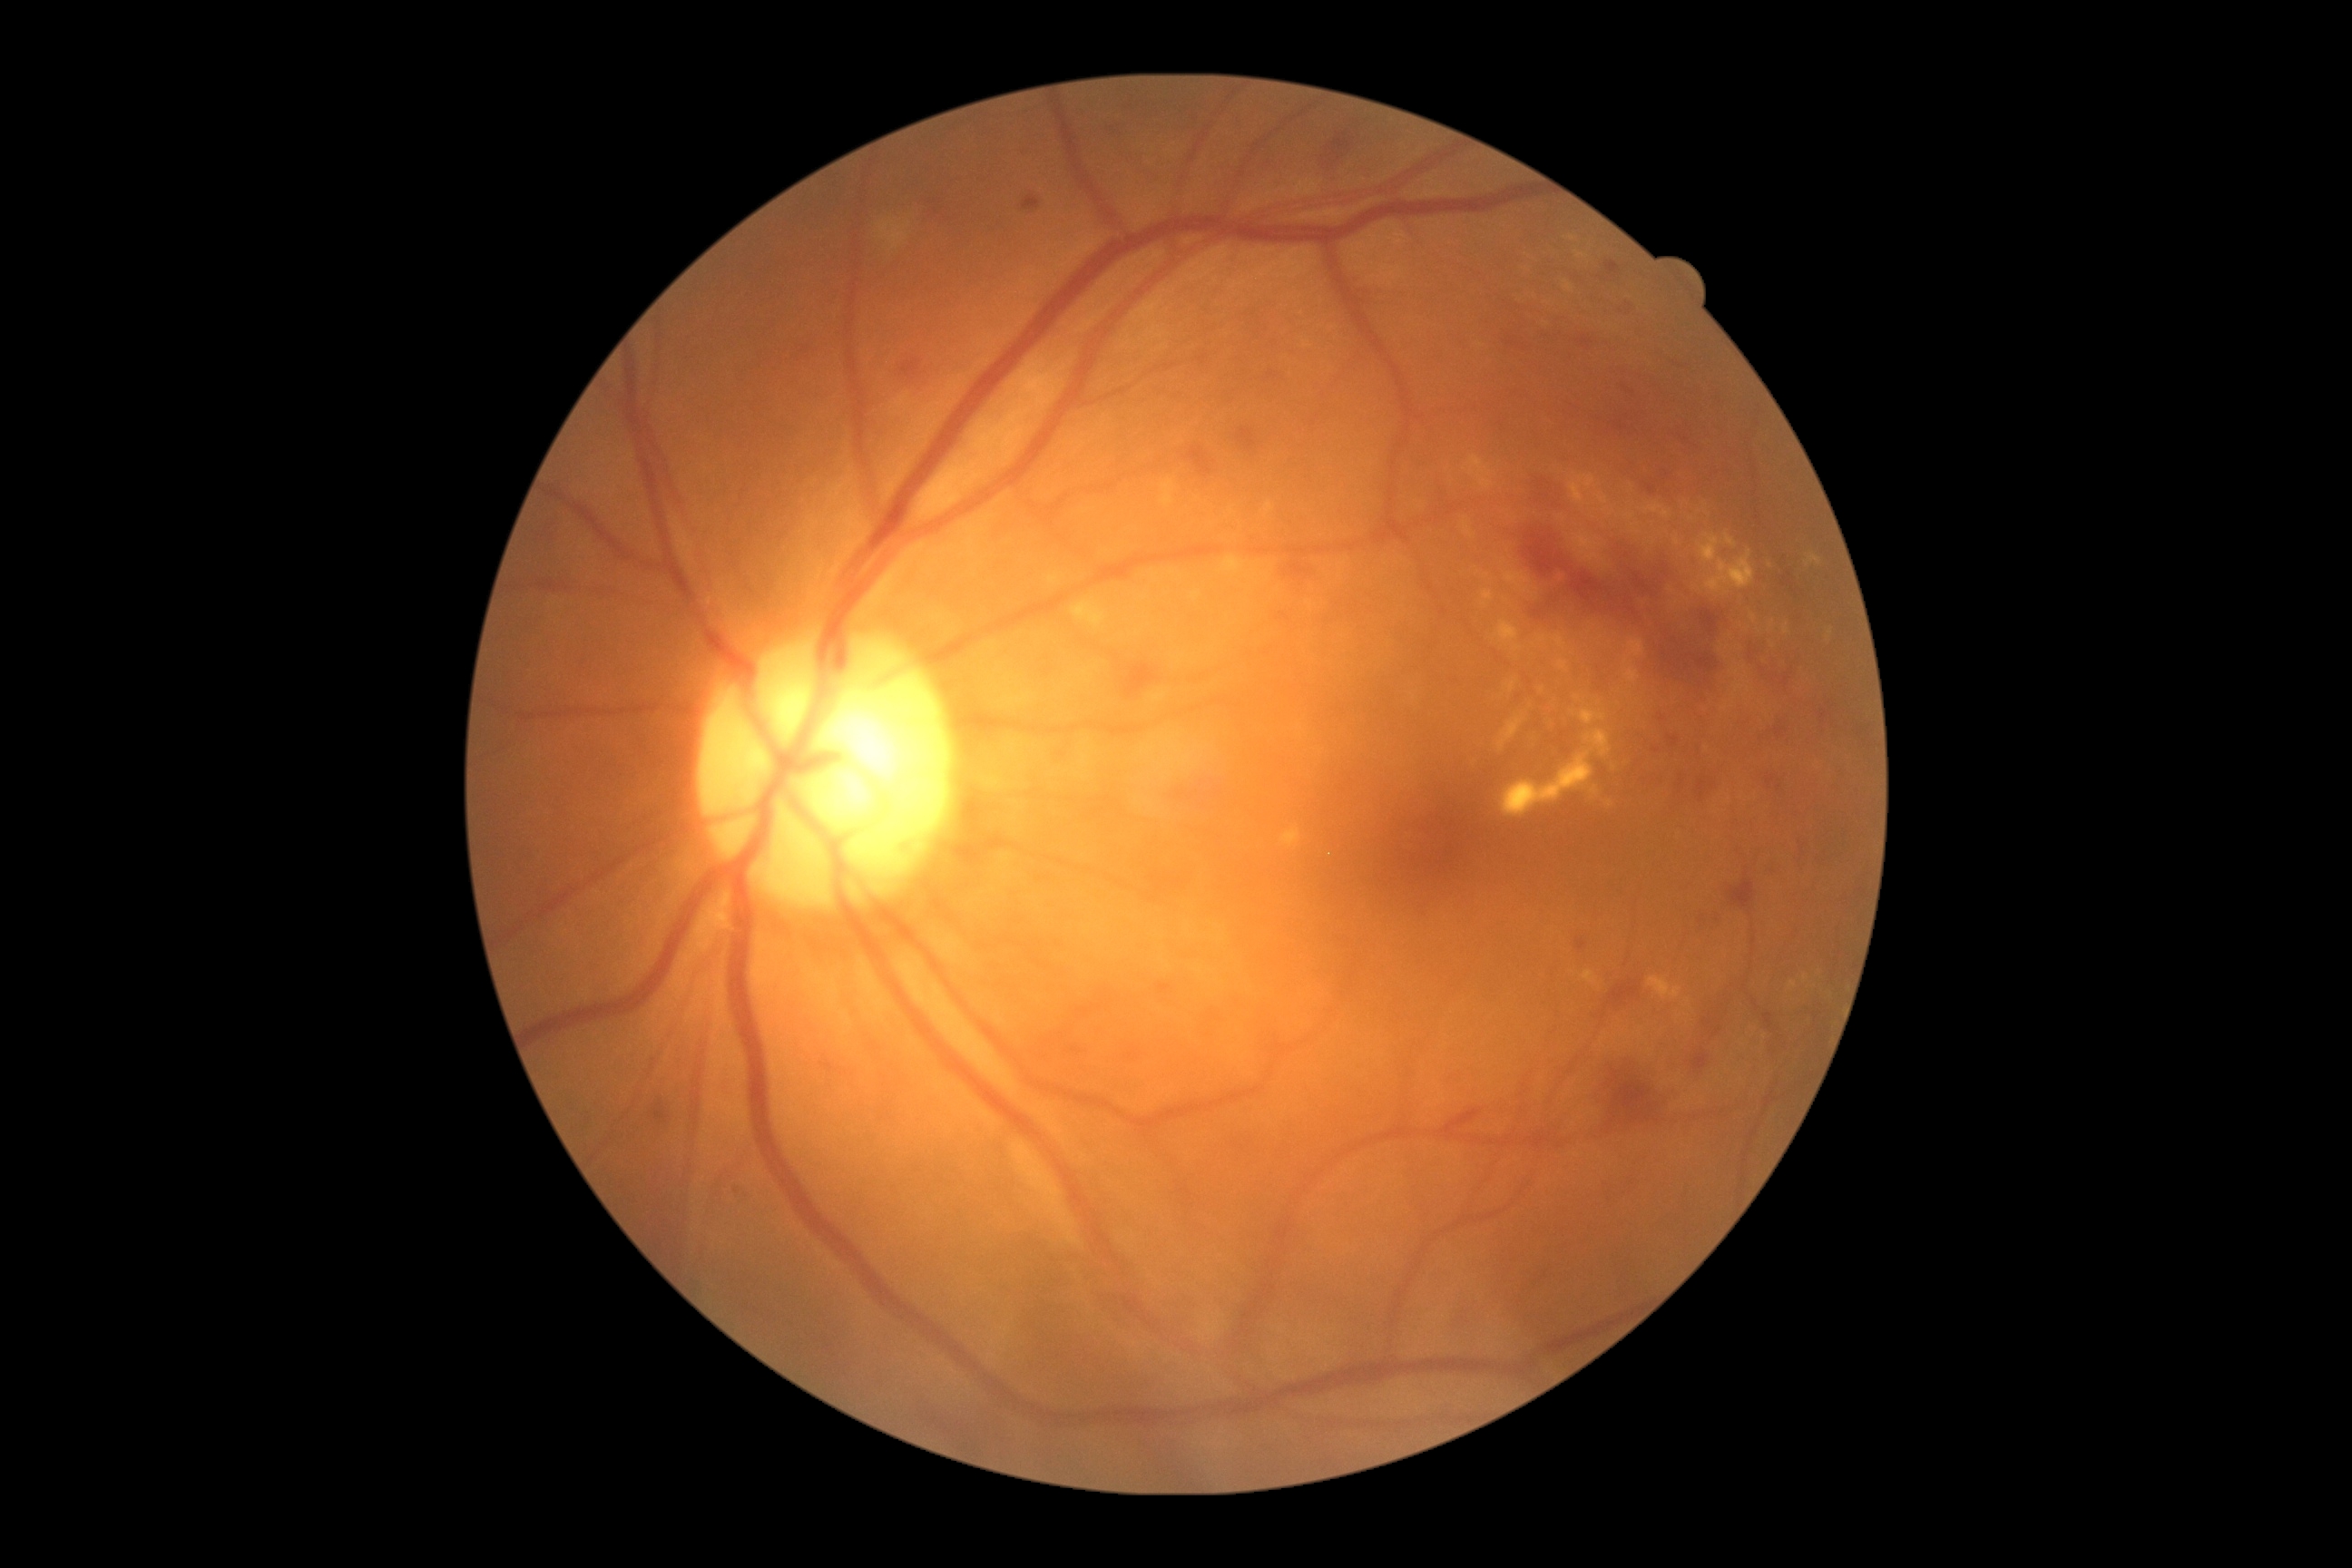
Diabetic retinopathy severity: 2
Lesions identified (partial list):
microaneurysms (partial): bbox(1128, 1052, 1137, 1059) | bbox(1612, 297, 1634, 318) | bbox(1647, 485, 1656, 496) | bbox(1073, 1048, 1081, 1054) | bbox(1776, 729, 1787, 740) | bbox(1023, 195, 1041, 211) | bbox(1576, 939, 1589, 950) | bbox(1057, 1088, 1066, 1092) | bbox(1157, 983, 1173, 995)
Smaller microaneurysms around Point(1093, 1006) | Point(1669, 475) | Point(1779, 787) | Point(1657, 751)
hard exudates (partial): bbox(1569, 473, 1596, 507) | bbox(1649, 977, 1683, 999) | bbox(1645, 504, 1661, 513) | bbox(1583, 970, 1598, 985) | bbox(1591, 787, 1600, 796) | bbox(877, 220, 912, 250) | bbox(1576, 251, 1587, 259) | bbox(1732, 667, 1745, 676) | bbox(1790, 981, 1798, 988) | bbox(1661, 511, 1672, 520) | bbox(1505, 573, 1533, 593) | bbox(1500, 750, 1594, 818) | bbox(1161, 480, 1175, 507) | bbox(1629, 640, 1645, 658) | bbox(1725, 534, 1738, 549)
Smaller hard exudates around Point(1503, 562) | Point(1725, 706) | Point(1505, 600) | Point(1831, 632) | Point(1707, 748)
soft exudates: none identified
hemorrhages (partial): bbox(1237, 429, 1257, 453) | bbox(1524, 460, 1562, 505) | bbox(1763, 1014, 1774, 1030) | bbox(1609, 1171, 1656, 1199) | bbox(1456, 1102, 1485, 1133) | bbox(1750, 631, 1796, 687) | bbox(1712, 908, 1729, 925) | bbox(1505, 527, 1732, 701) | bbox(1692, 1050, 1709, 1072) | bbox(1712, 1028, 1721, 1039) | bbox(1188, 447, 1211, 476)
Smaller hemorrhages around Point(660, 1105)